Pediatric wide-field fundus photograph. Clarity RetCam 3, 130° FOV.
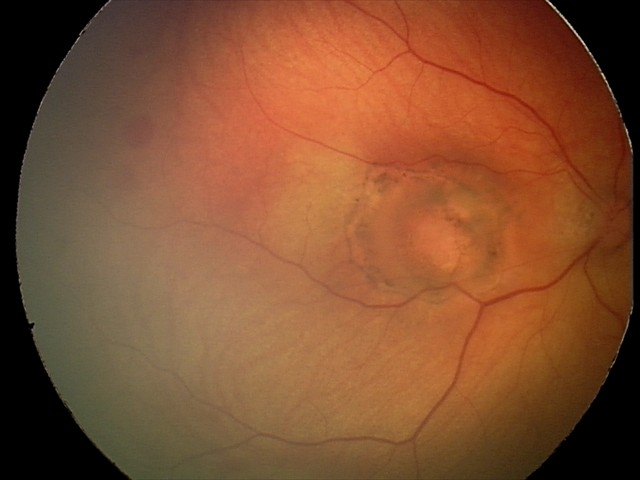

Screening series with toxoplasmosis chorioretinitis.